RetCam wide-field infant fundus image; 130° field of view (Natus RetCam Envision); 1440 x 1080 pixels
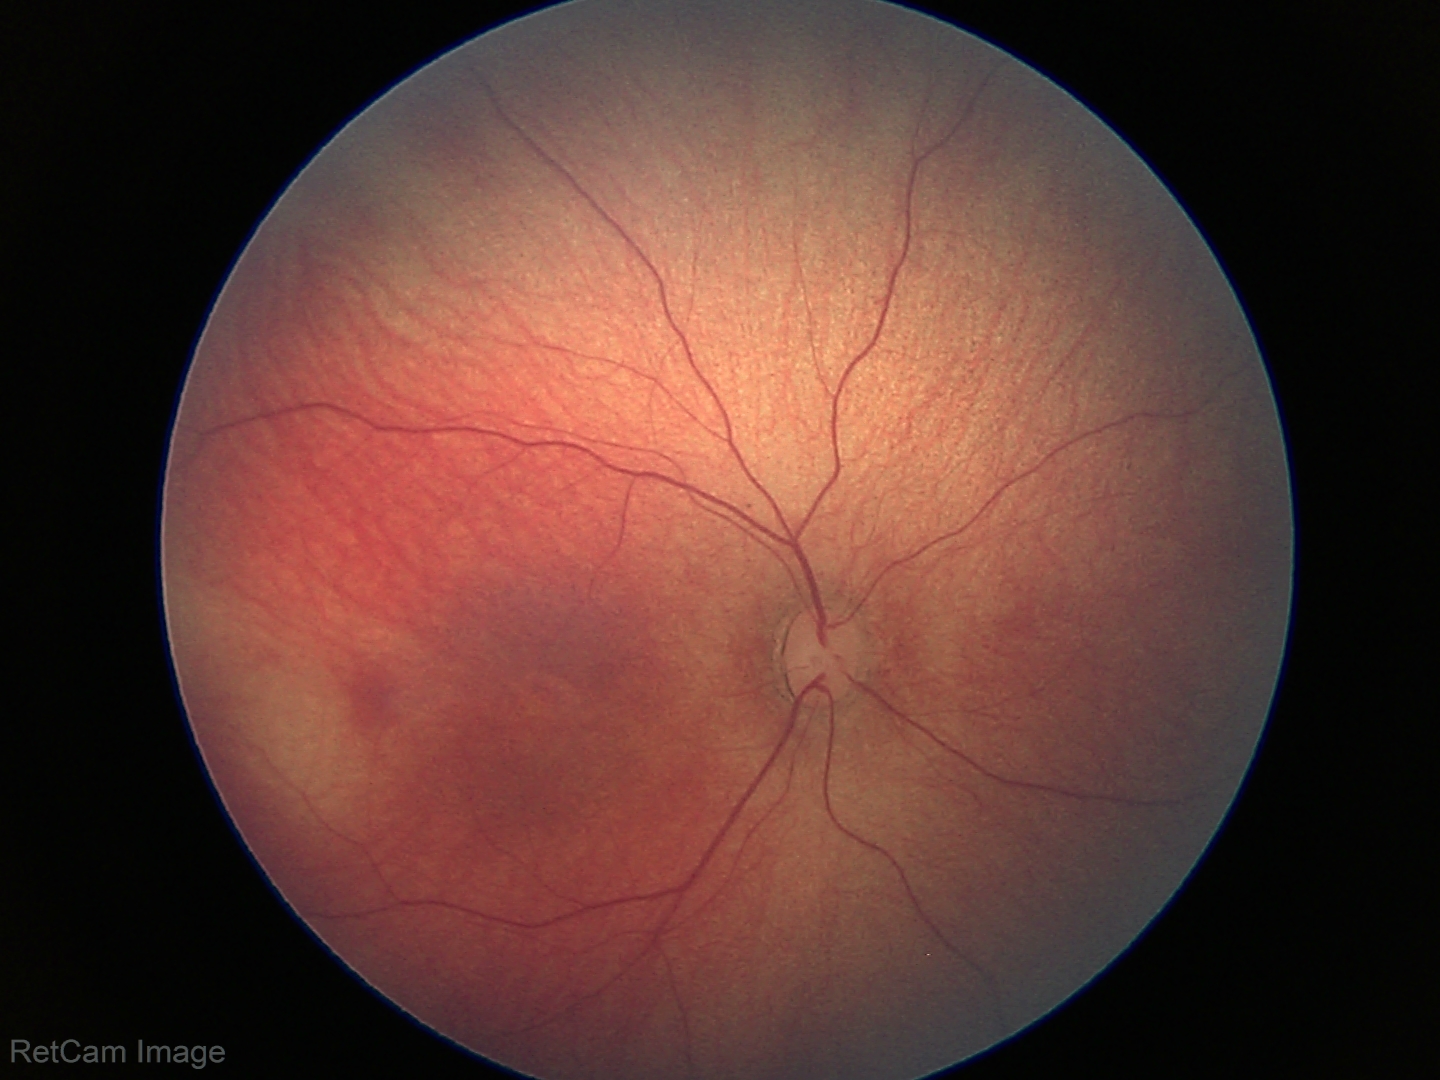 Screening diagnosis = no pathology identified.